Color fundus photograph from a handheld portable camera:
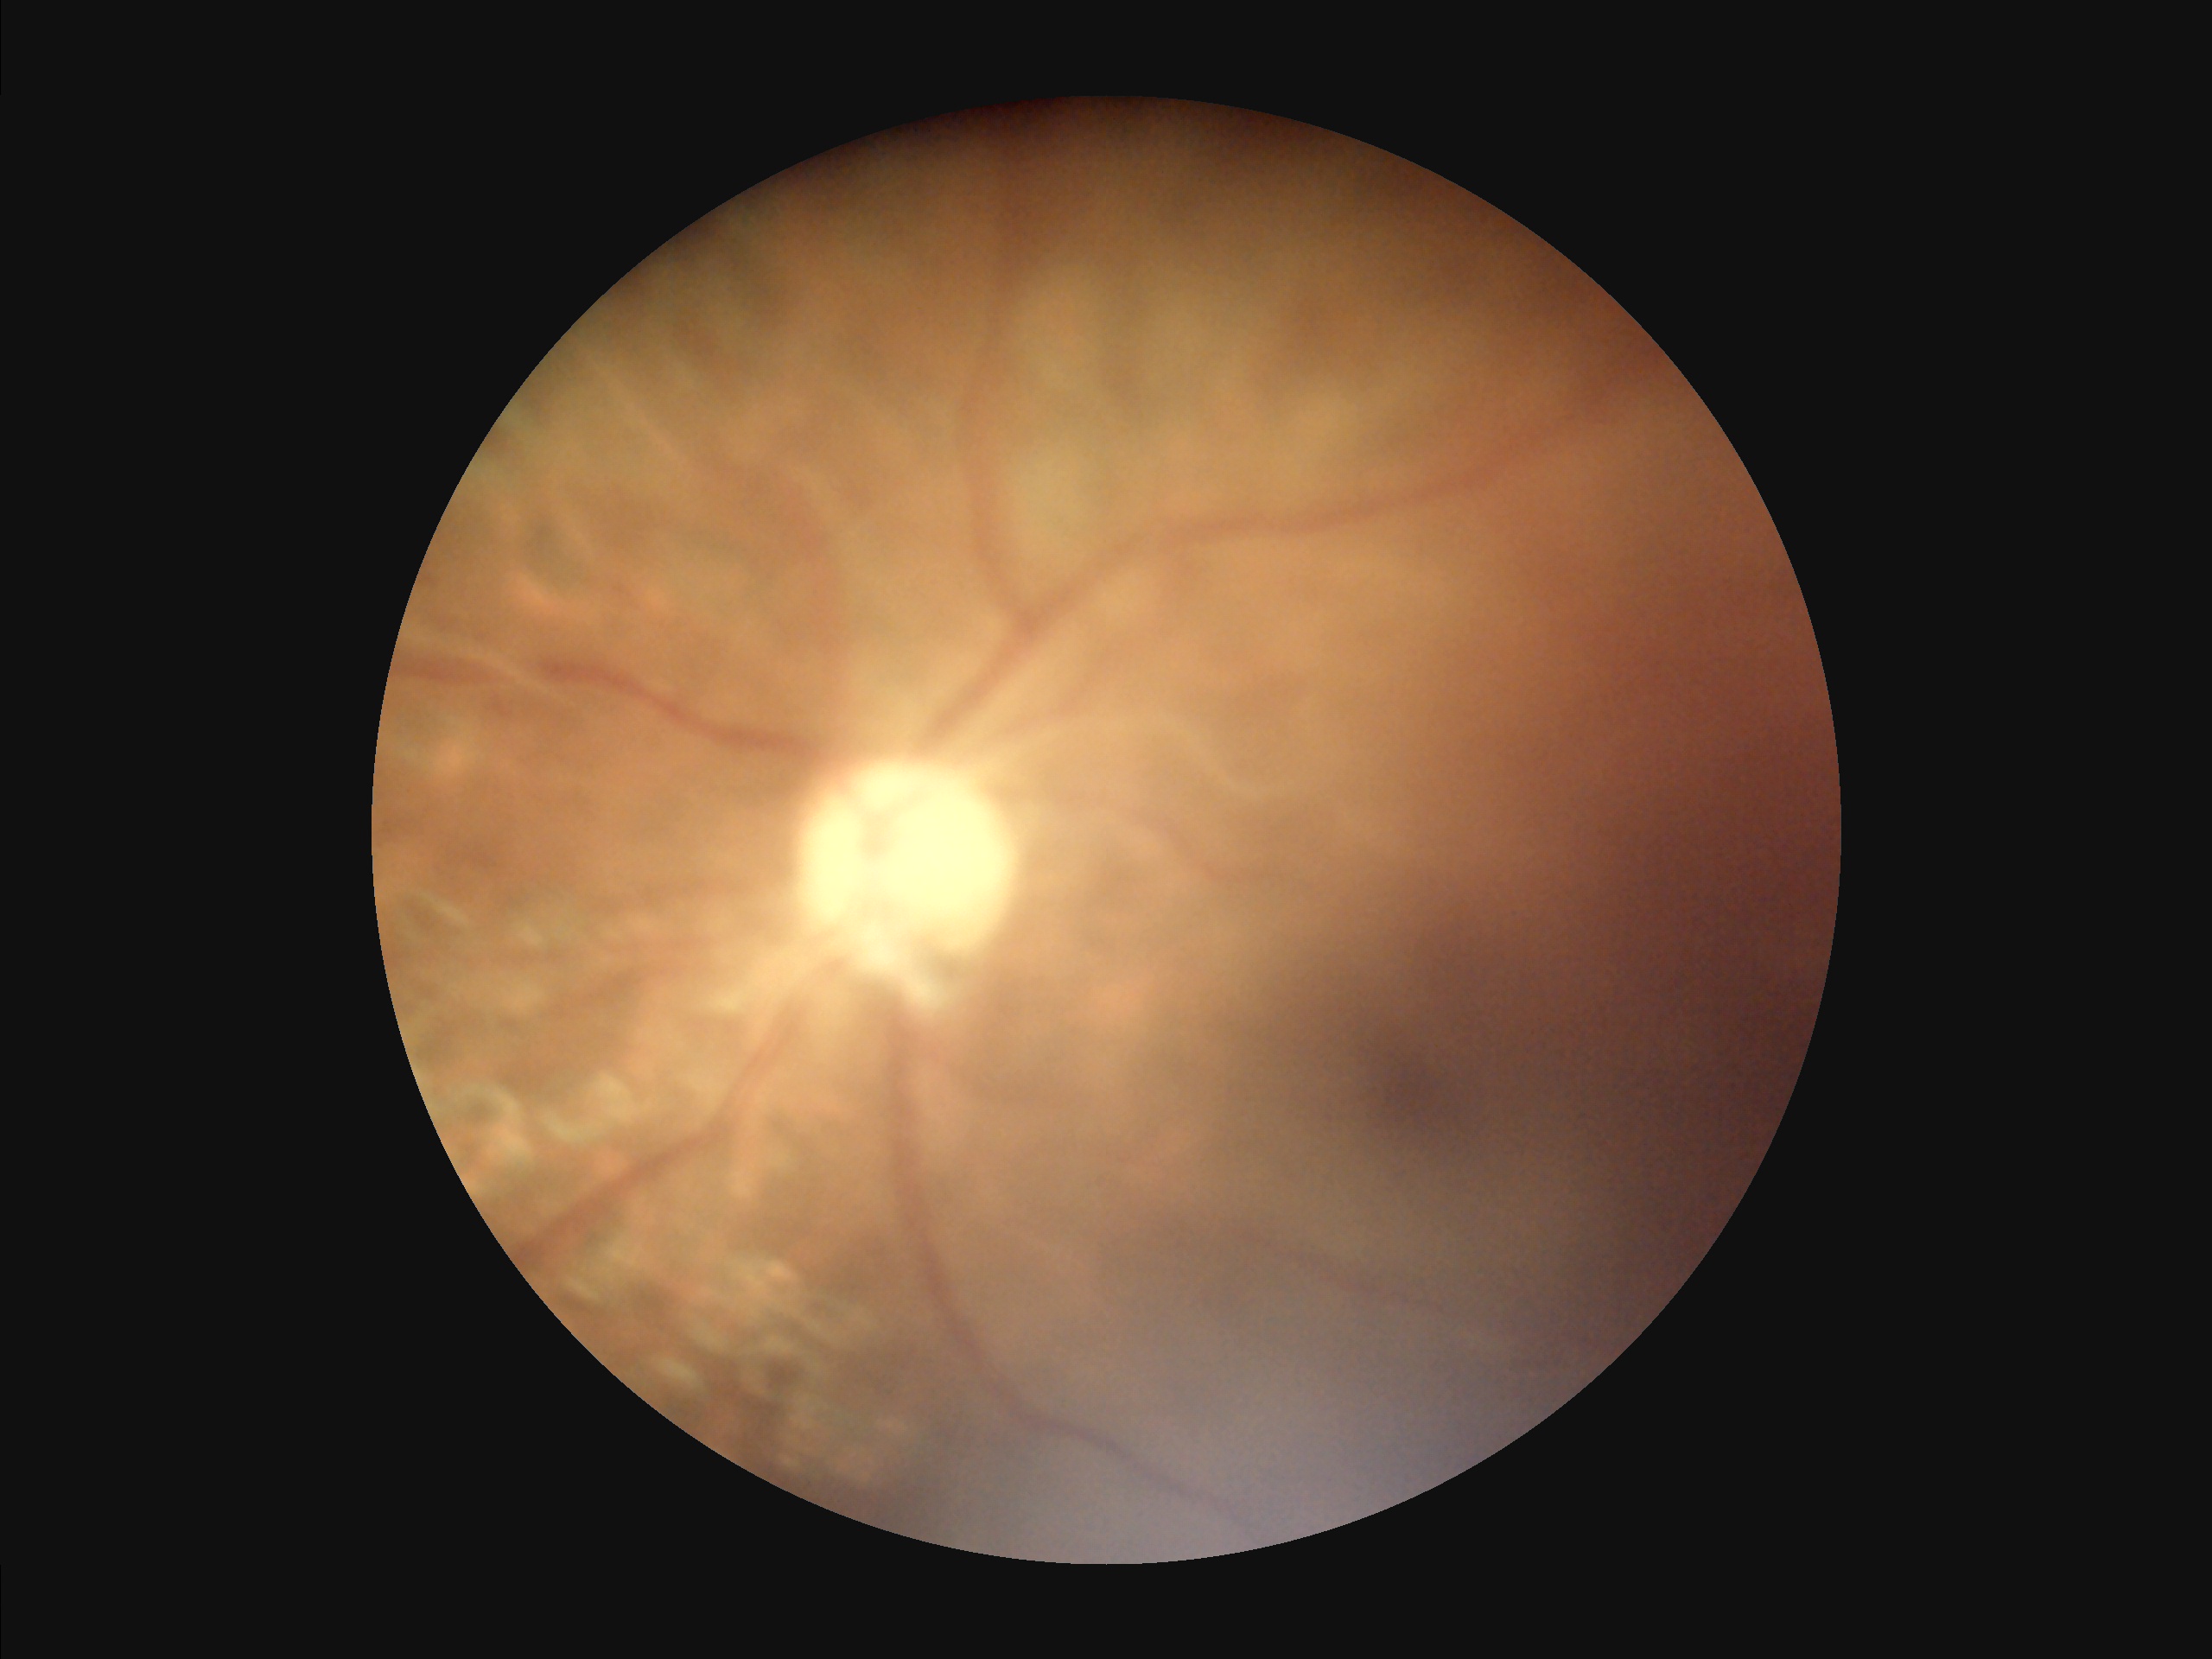

{"overall_quality": "inadequate for clinical interpretation", "contrast": "poor dynamic range", "clarity": "noticeable blur in the optic disc, vessels, or background", "illumination": "uniform, no color cast"}